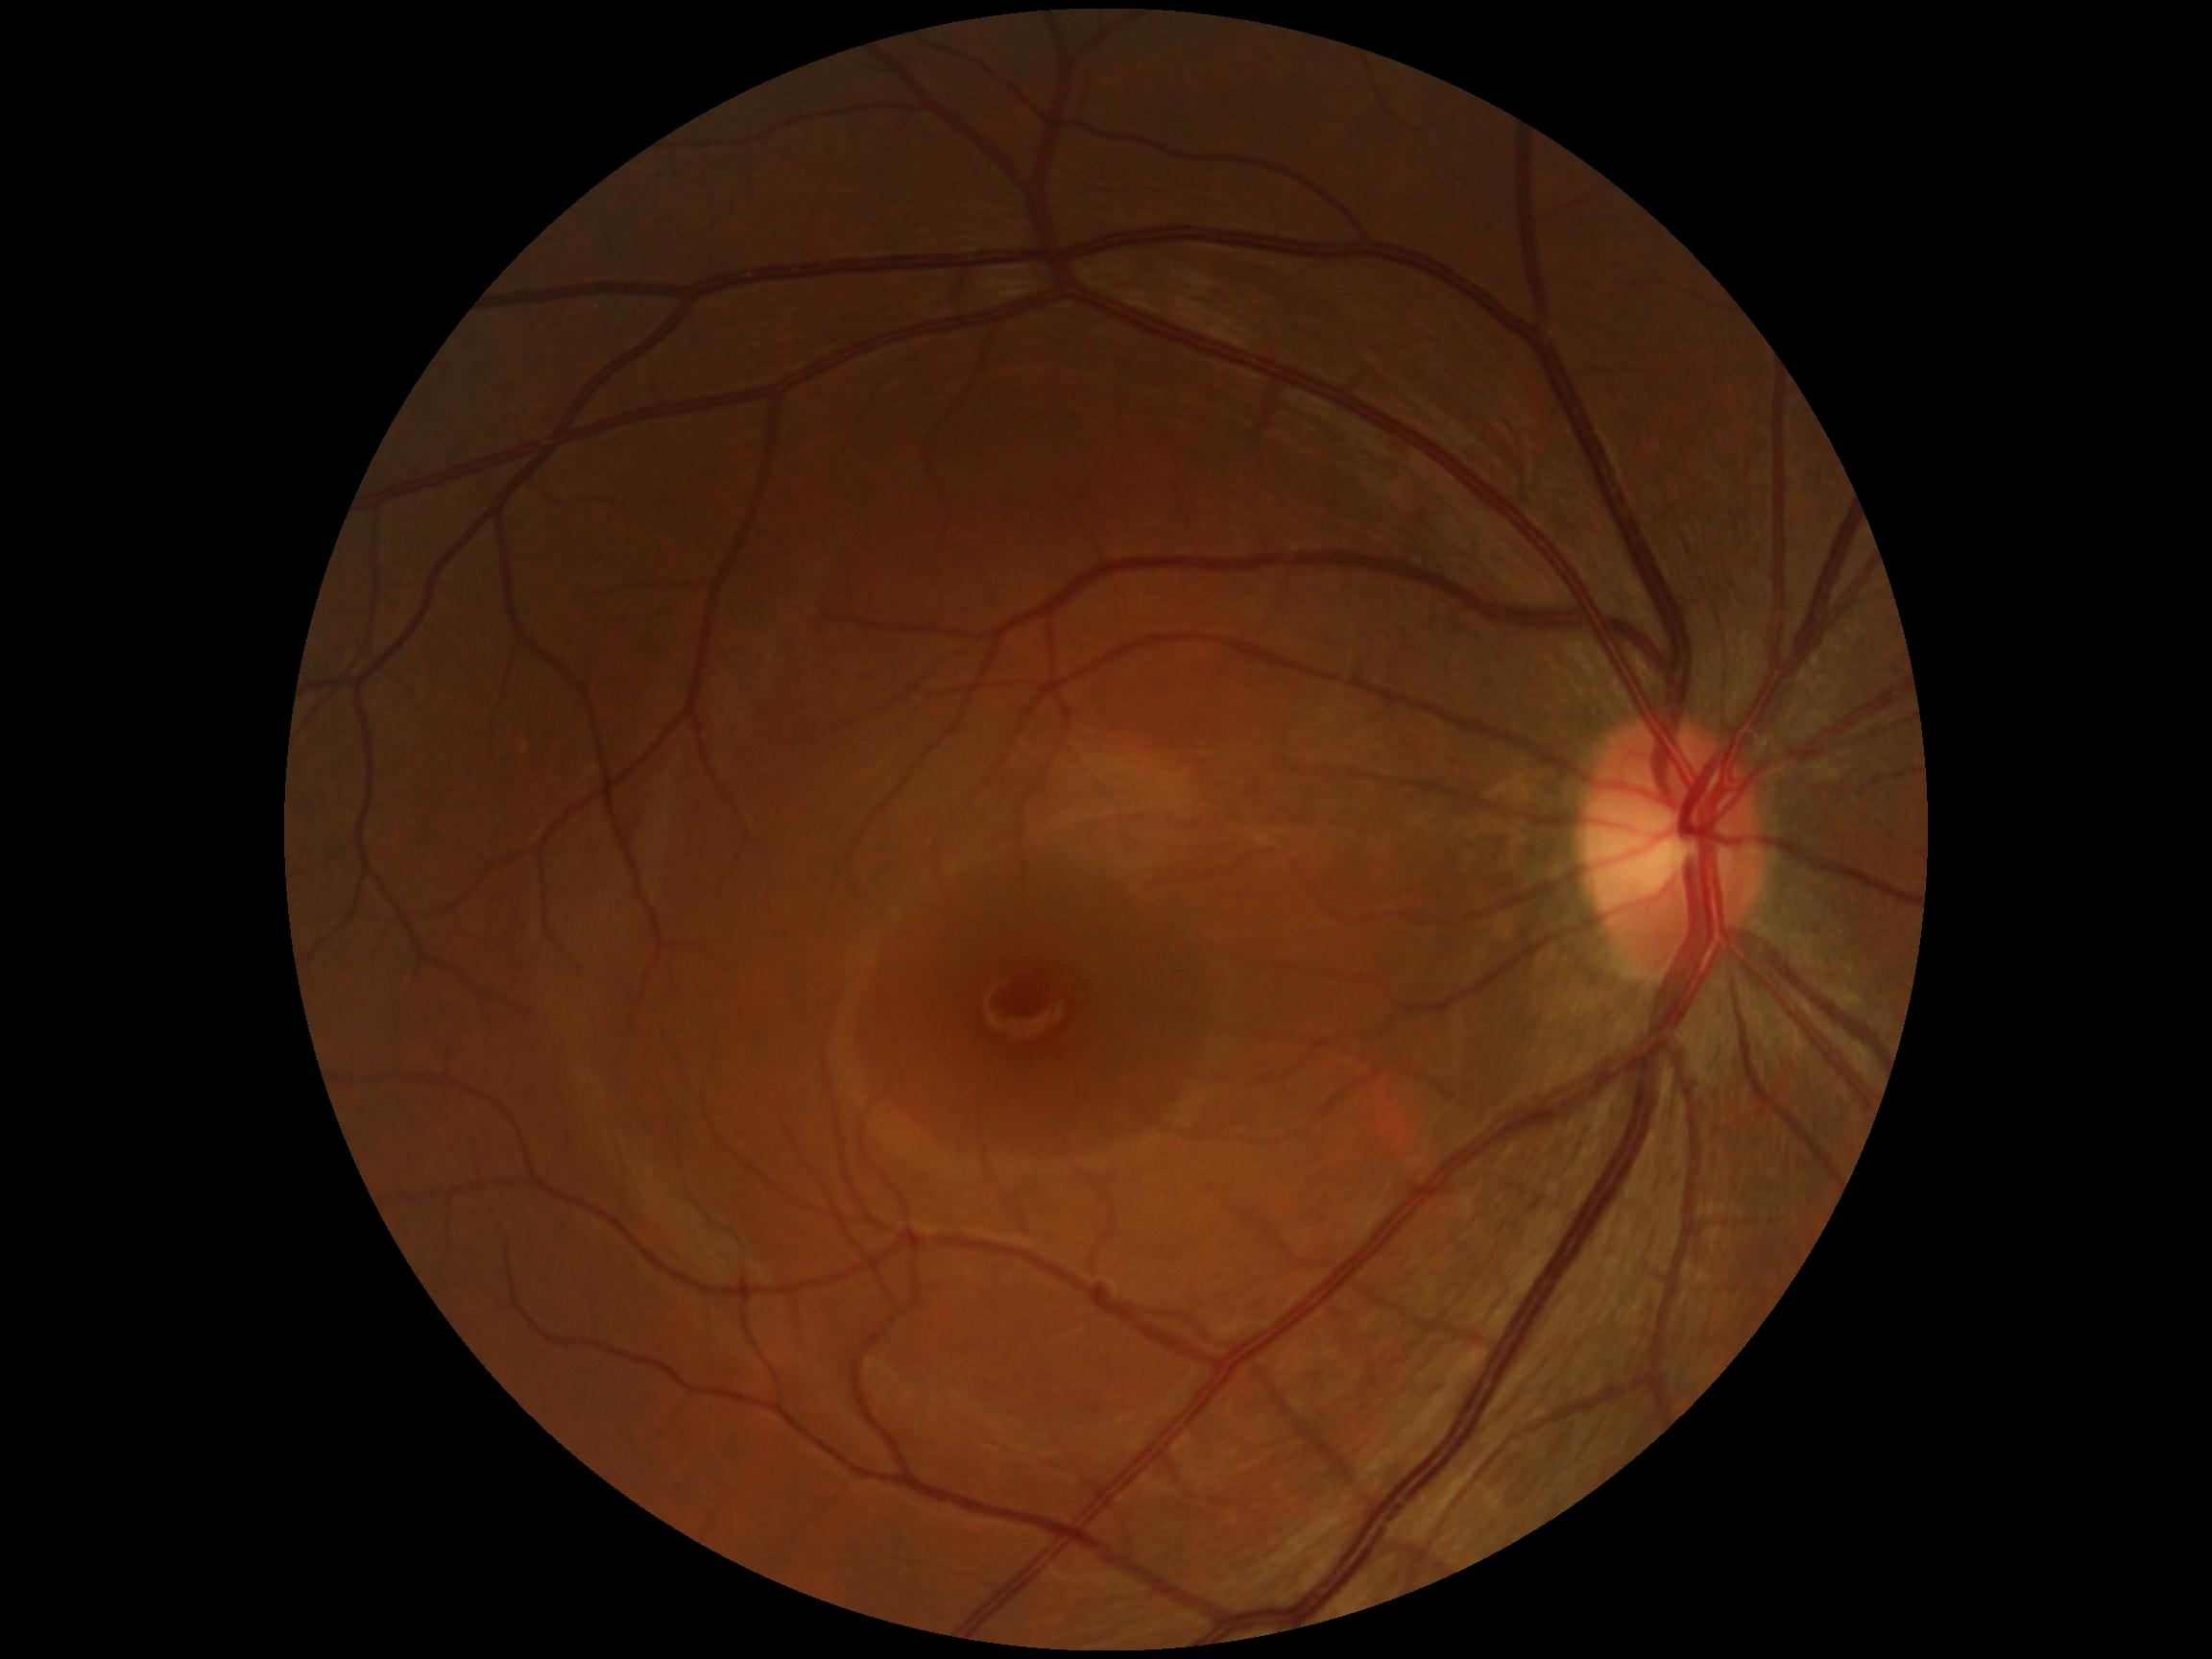

DR impression=no DR findings; retinopathy grade=0/4.